45 degree fundus photograph; fundus photo; acquired with a NIDEK AFC-230; without pupil dilation; 848 by 848 pixels — 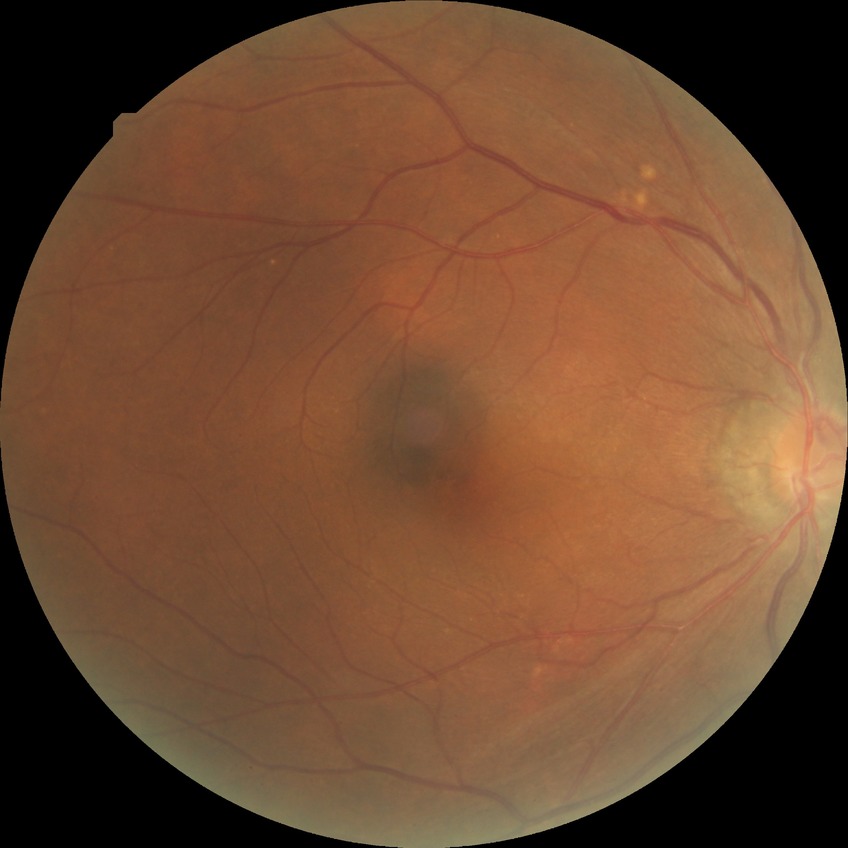
Davis grading = no diabetic retinopathy.